Color fundus photograph. 45° FOV: 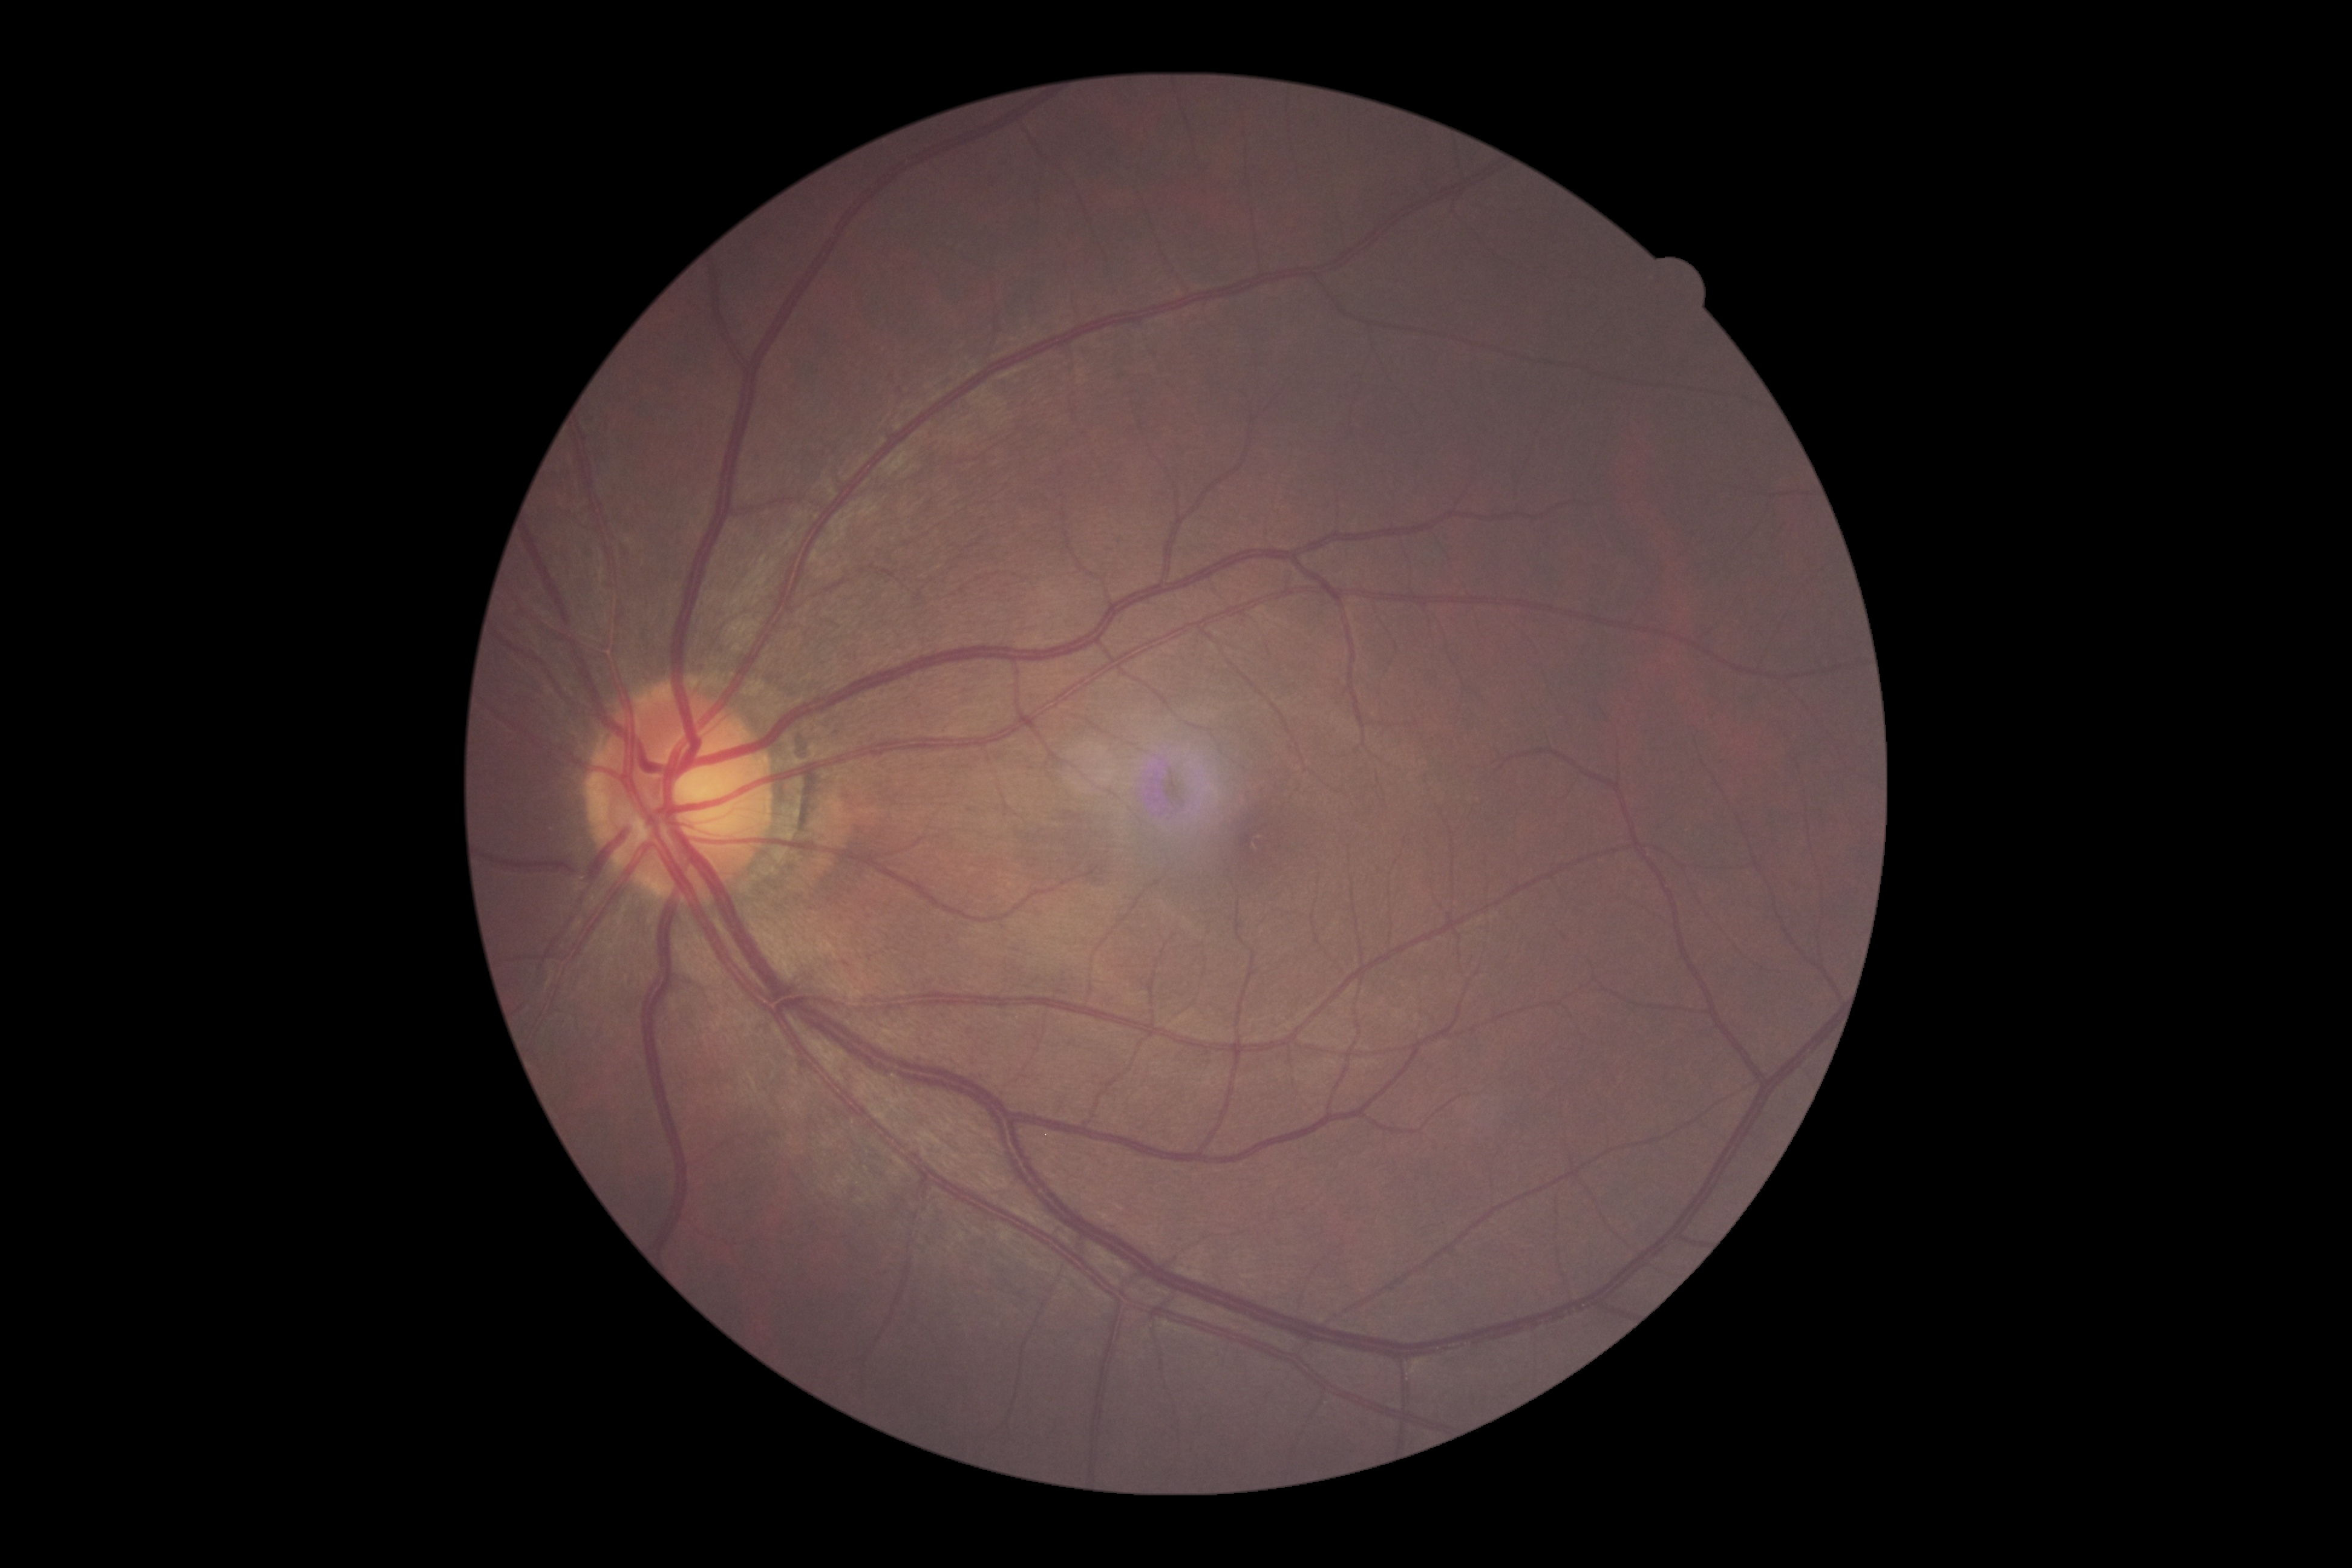
Diabetic retinopathy (DR) is 0.